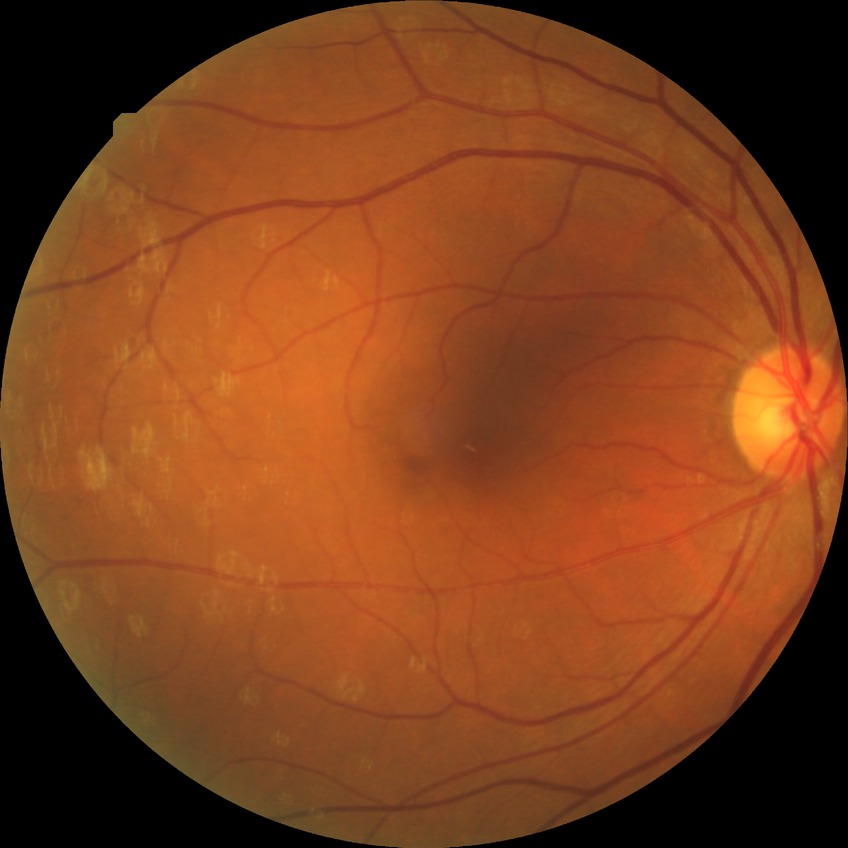
Diabetic retinopathy (DR): NDR (no diabetic retinopathy).